100° field of view (Phoenix ICON). Infant wide-field fundus photograph:
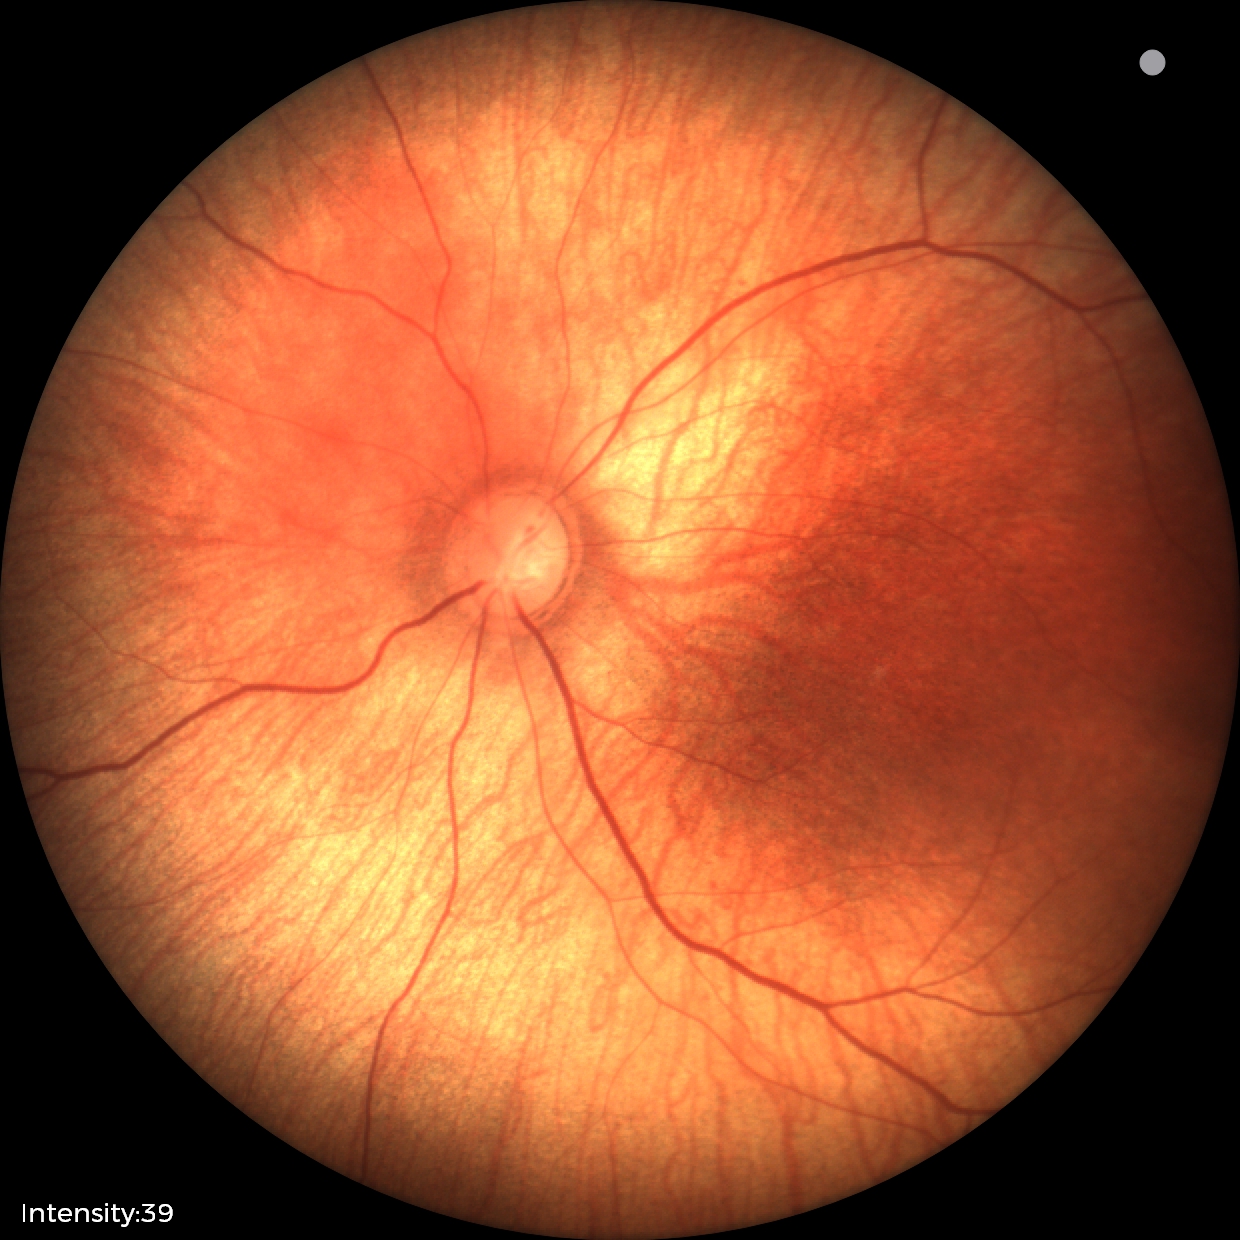 Diagnosis = no pathology identified